2352 by 1568 pixels:
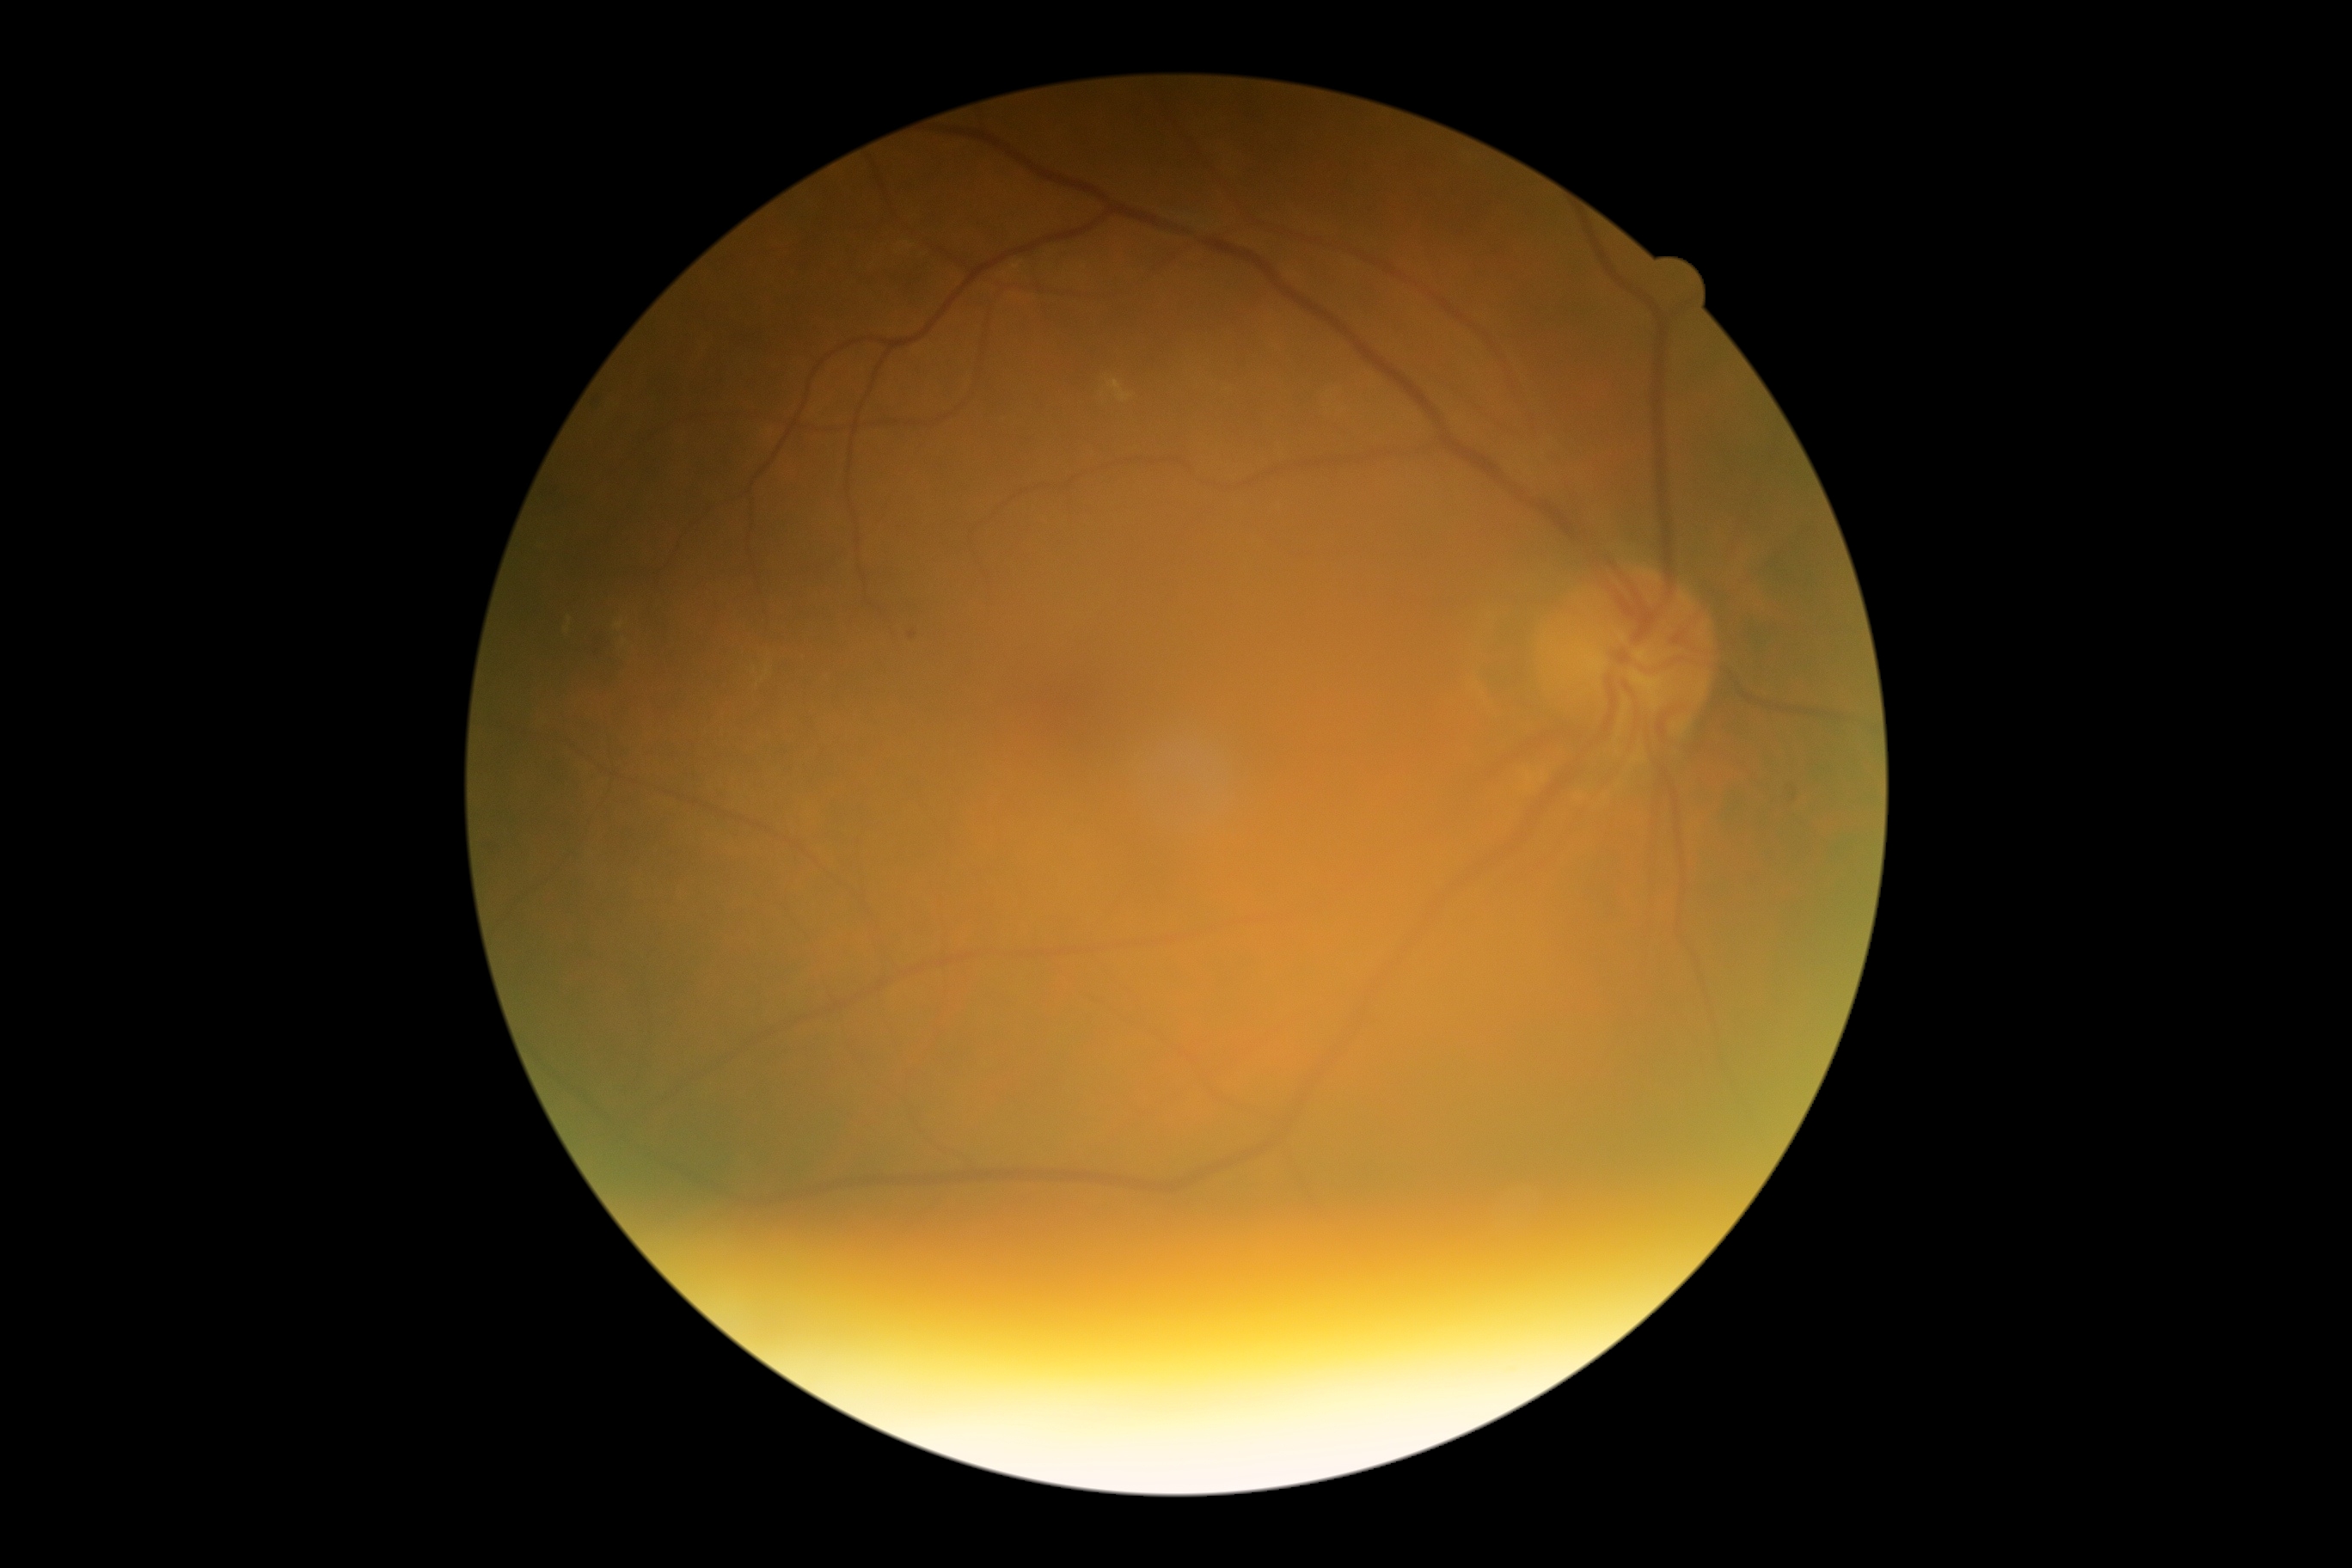
DR is grade 2 (moderate NPDR).